NIDEK AFC-230; graded on the modified Davis scale: 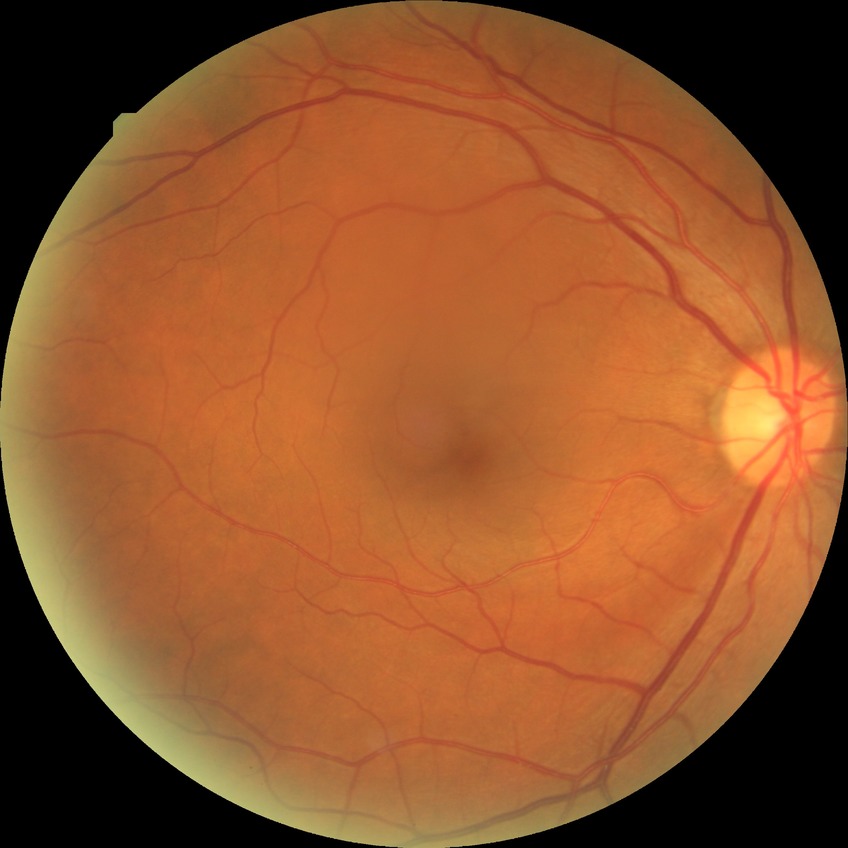

Diabetic retinopathy (DR): NDR (no diabetic retinopathy).